Retinal fundus photograph · 2212 by 1659 pixels.
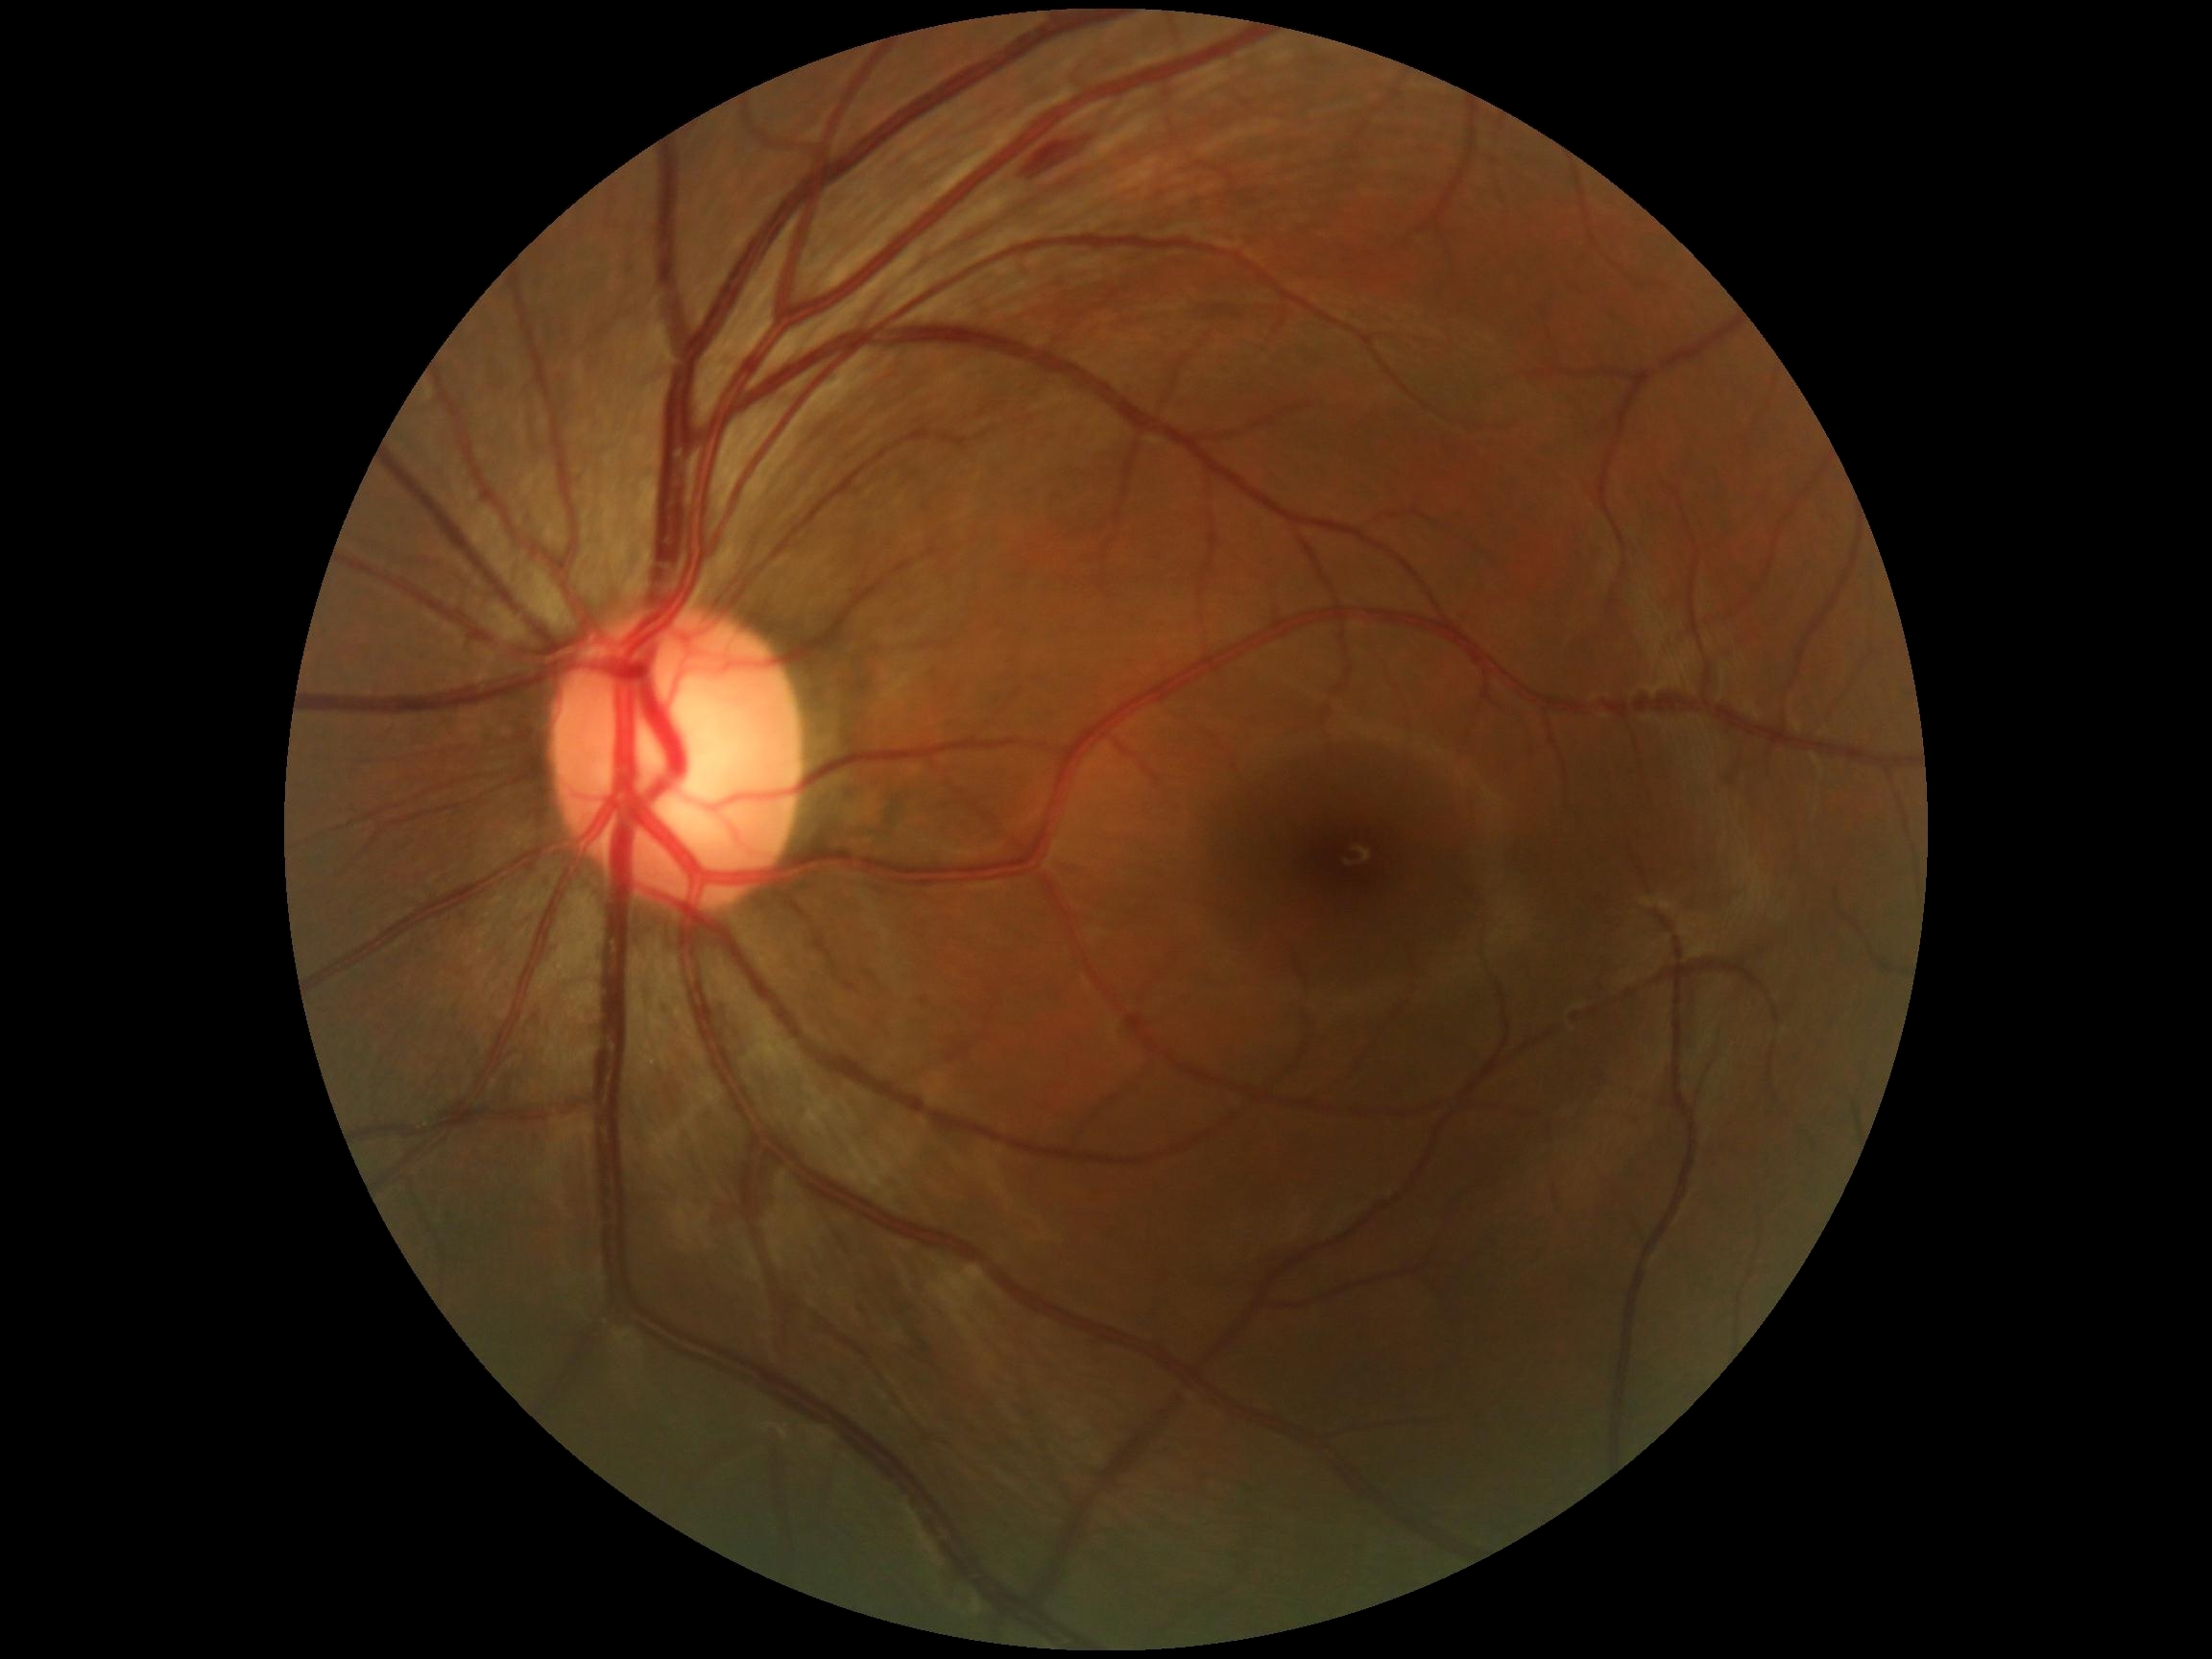
Disease class: non-proliferative diabetic retinopathy.
Diabetic retinopathy (DR): 2.